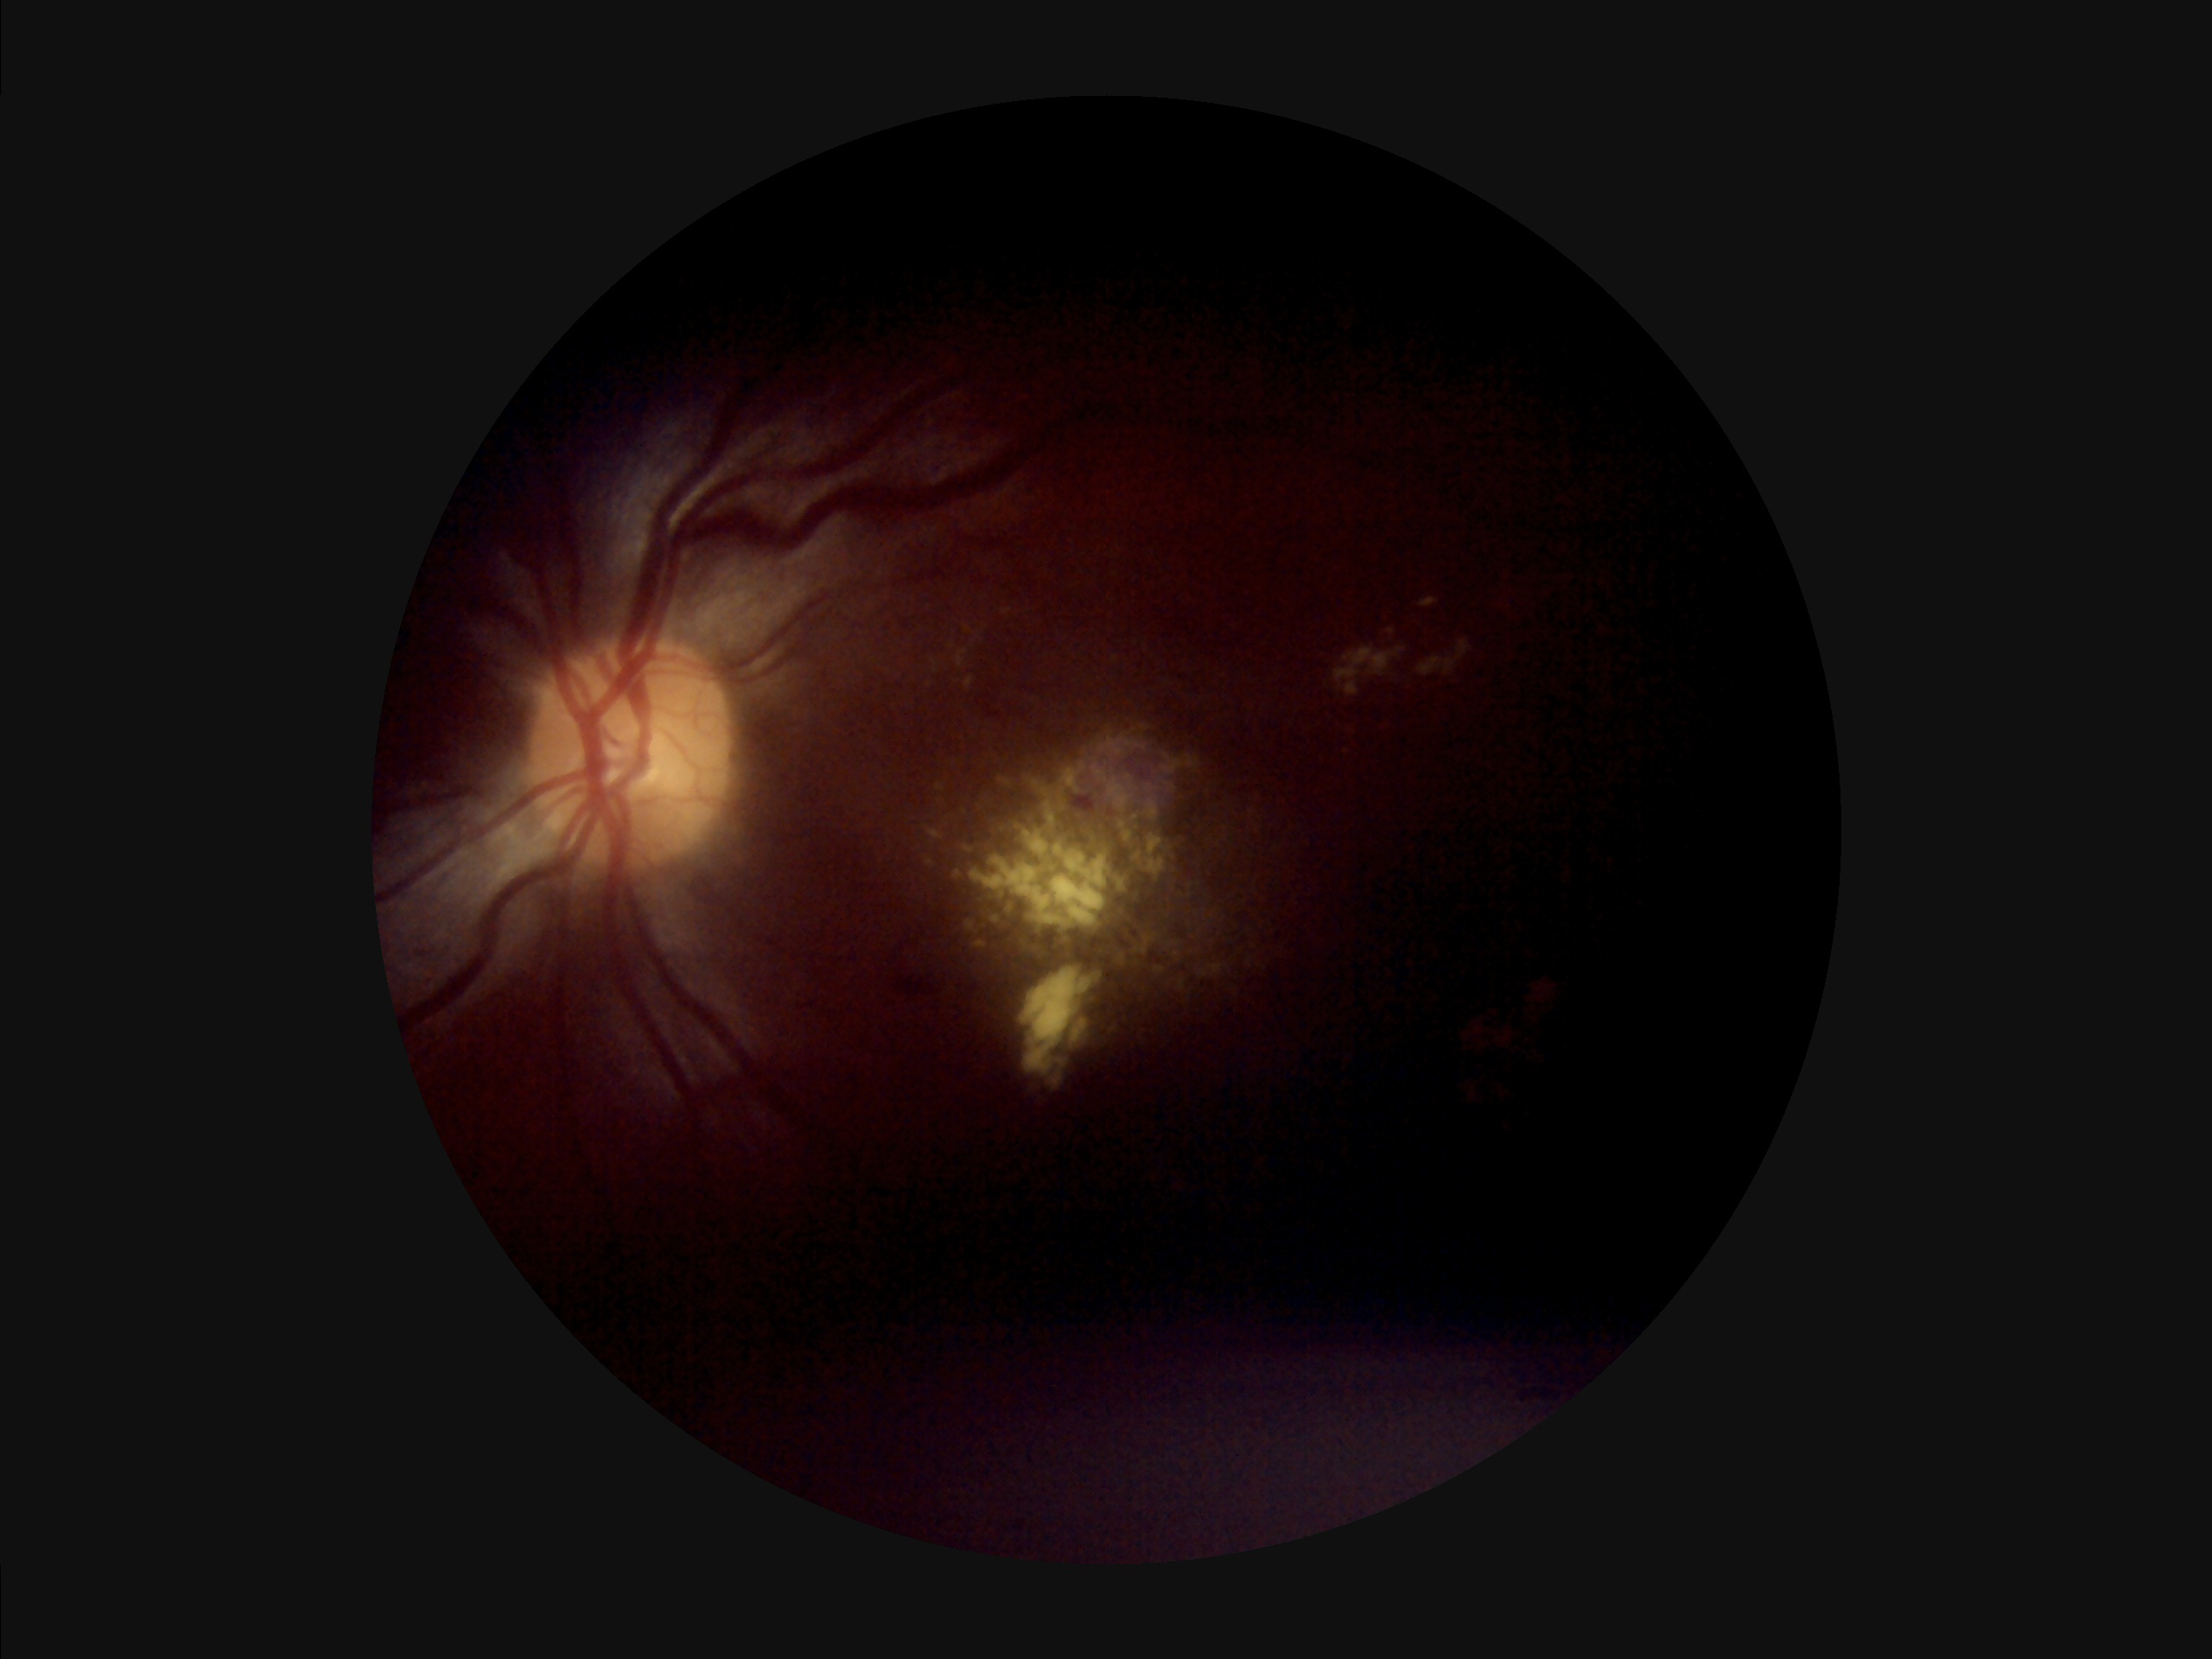

Poor illumination with uneven exposure. Contrast is low. Image quality is suboptimal. The image is blurry.